CFP, Davis DR grading
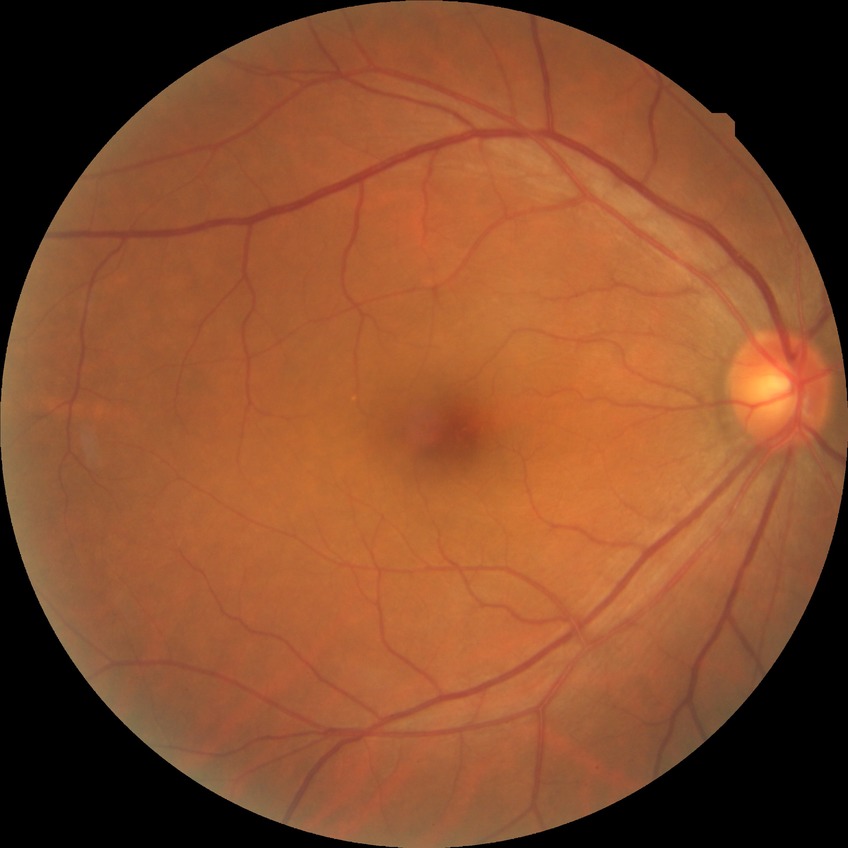

Diabetic retinopathy (DR) is NDR (no diabetic retinopathy).